848x848px. 45 degree fundus photograph: 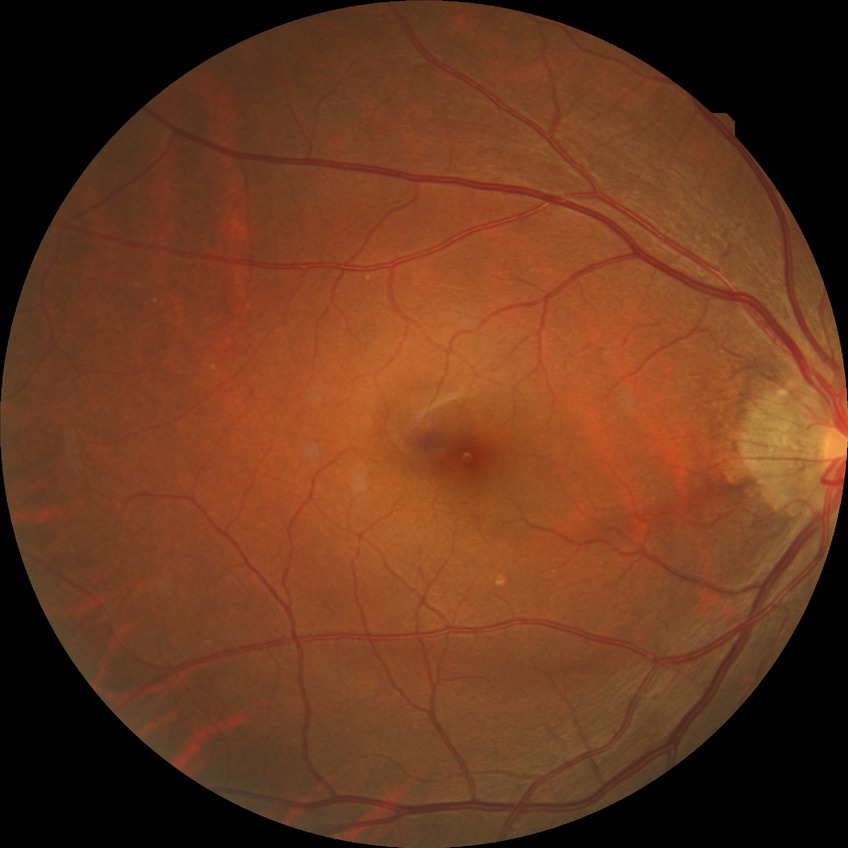

Diabetic retinopathy (DR): simple diabetic retinopathy (SDR).